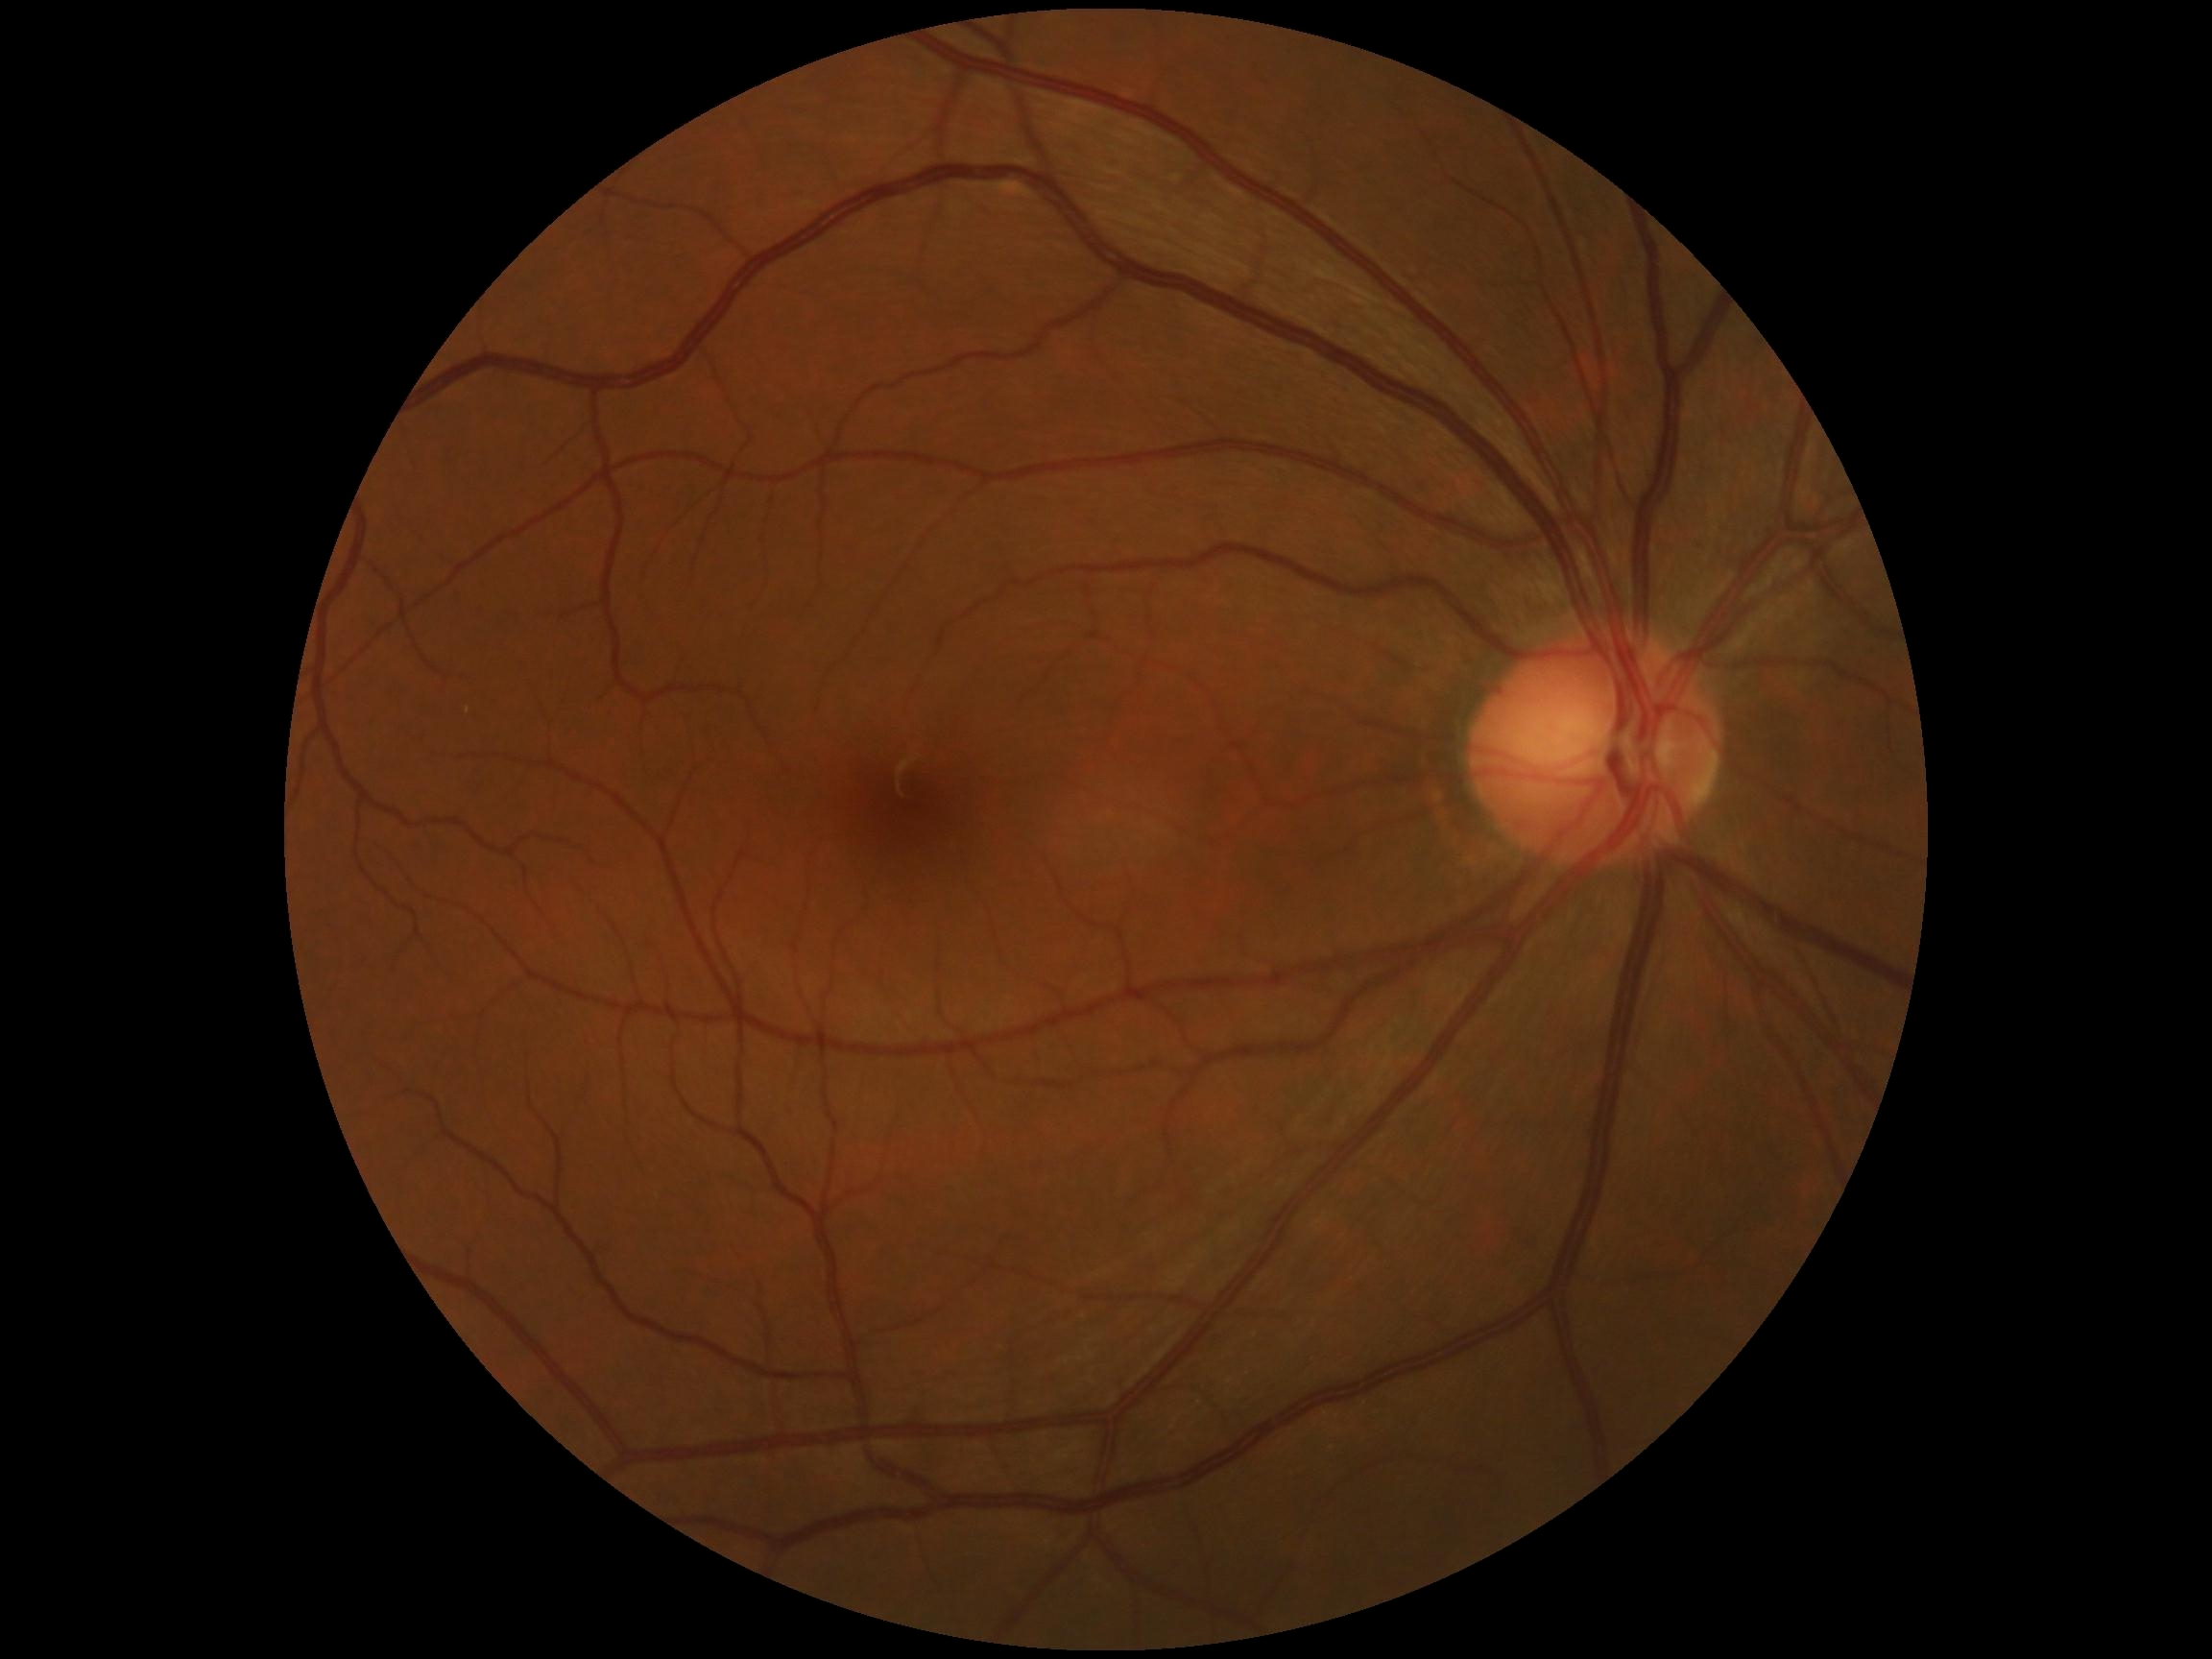 DR grade: 0 (no apparent retinopathy).